No pharmacologic dilation · retinal fundus photograph · modified Davis classification: 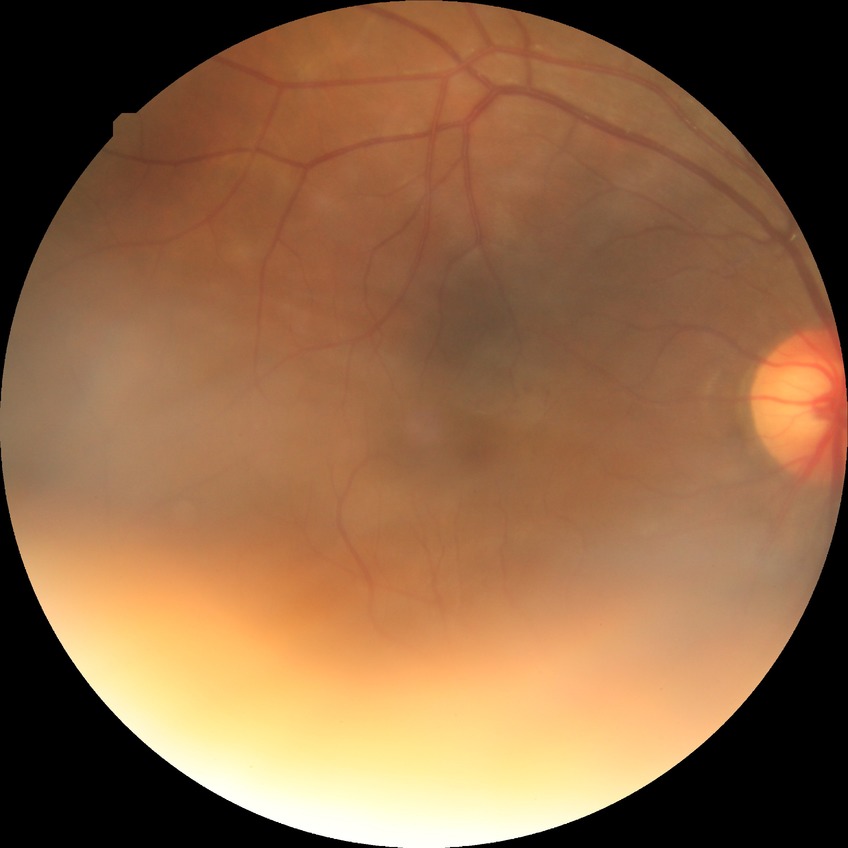

{
  "proliferative_class": "non-proliferative diabetic retinopathy",
  "davis_grade": "simple diabetic retinopathy (SDR)"
}